45-degree field of view. CFP. 2048 by 1536 pixels — 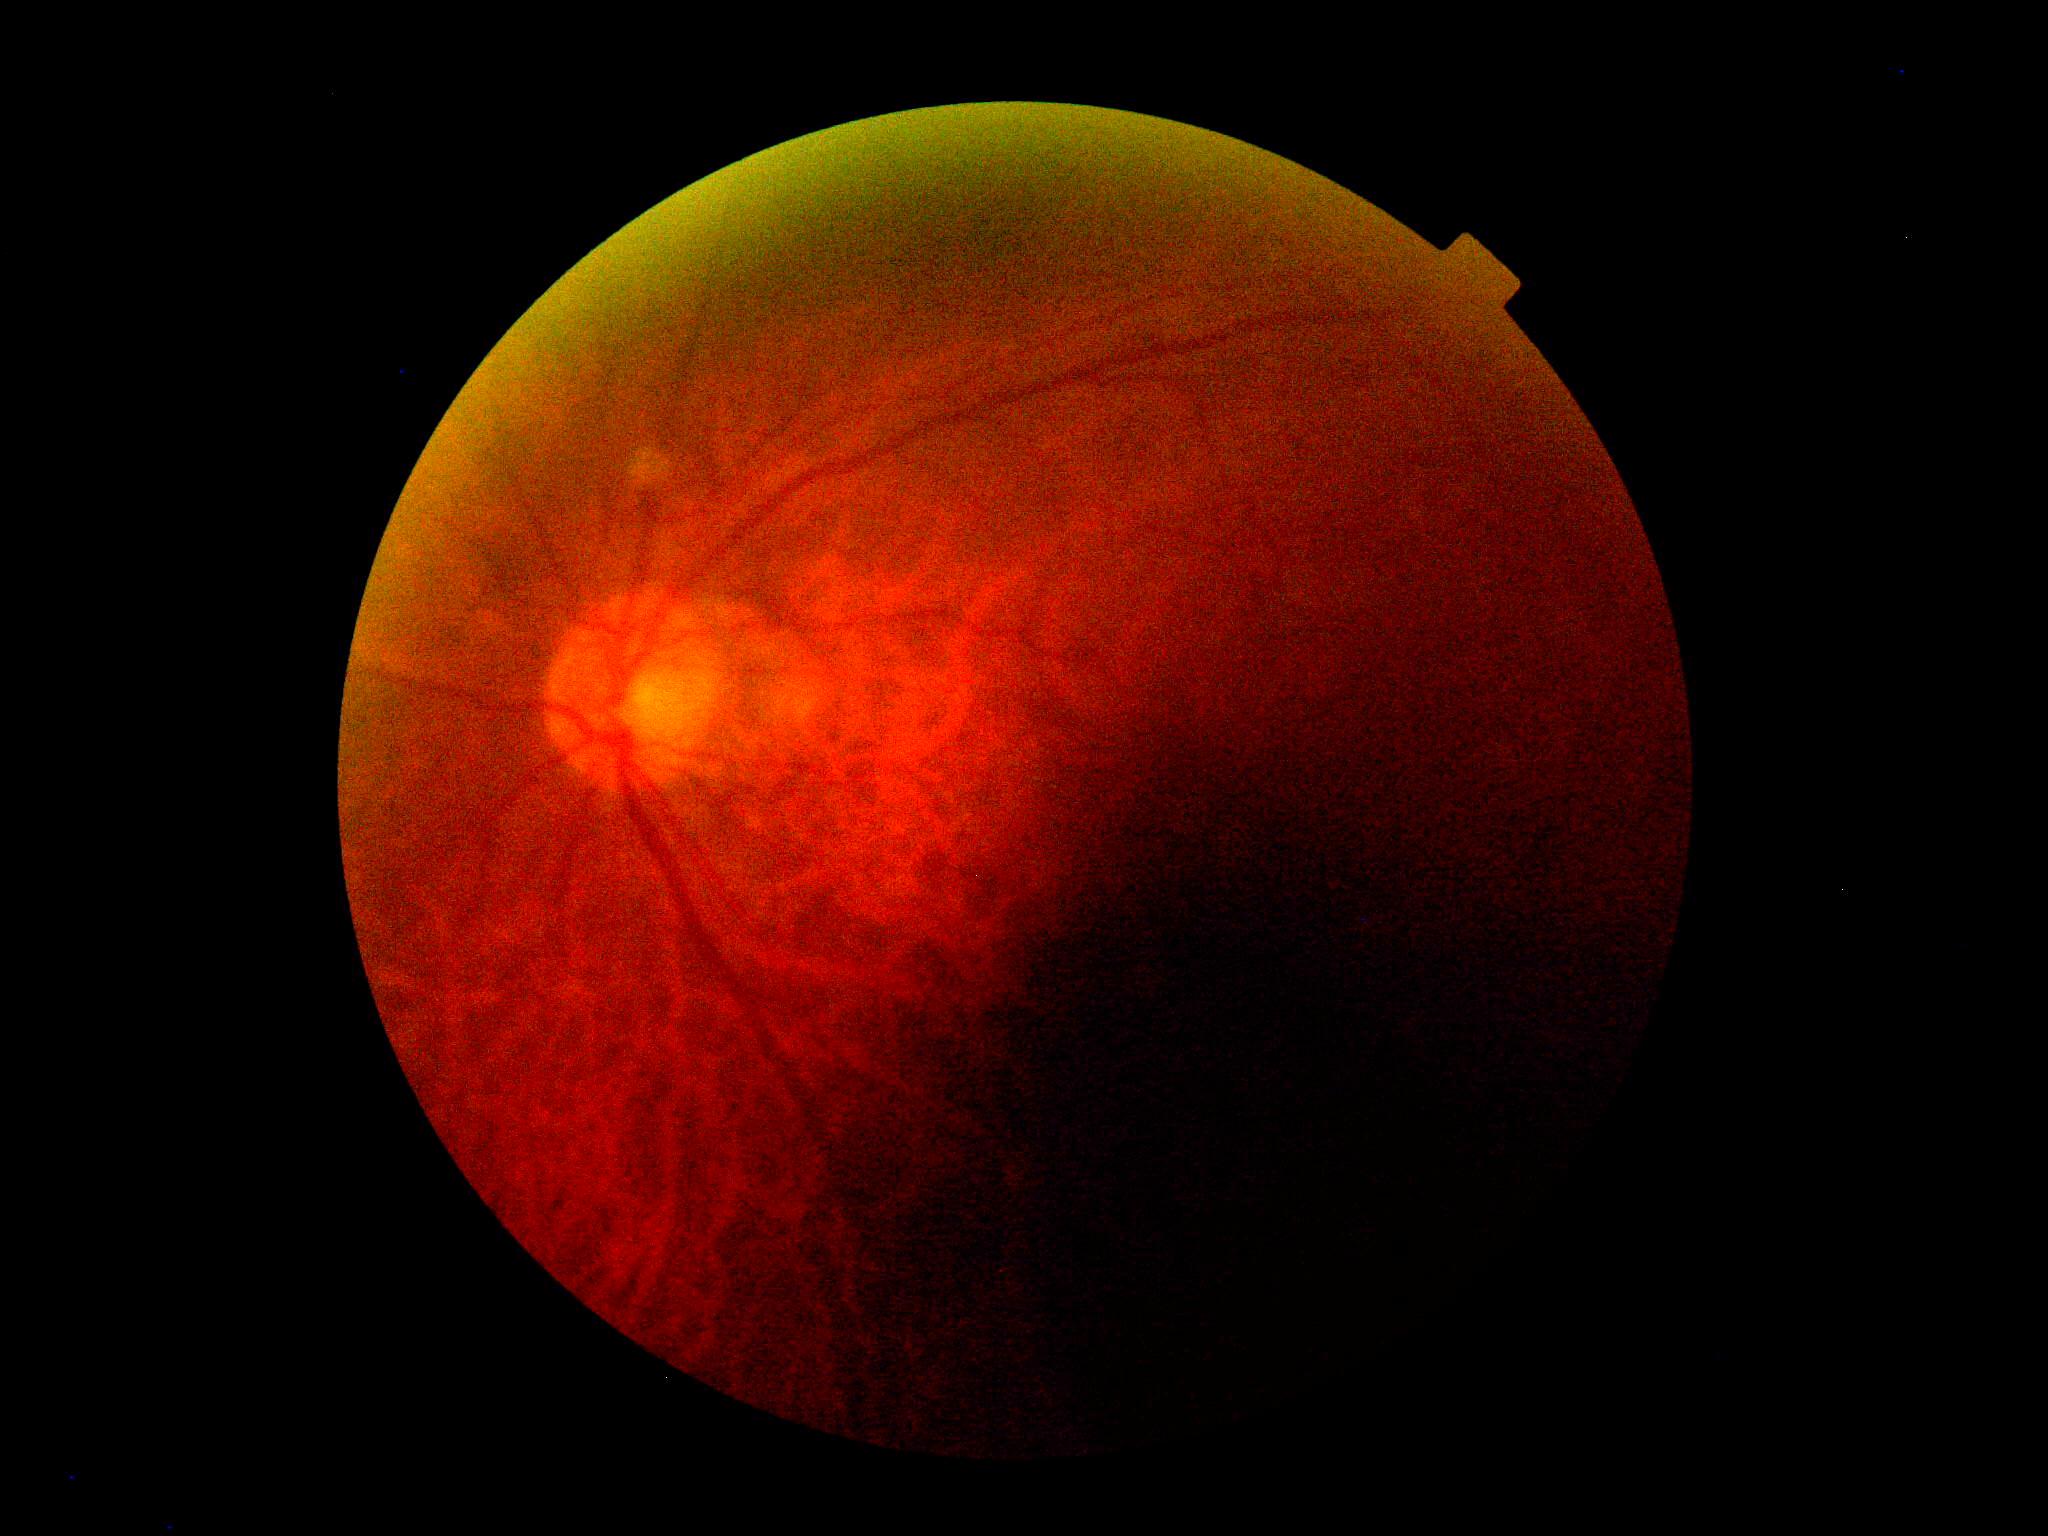 Retinopathy grade is ungradable due to poor image quality.